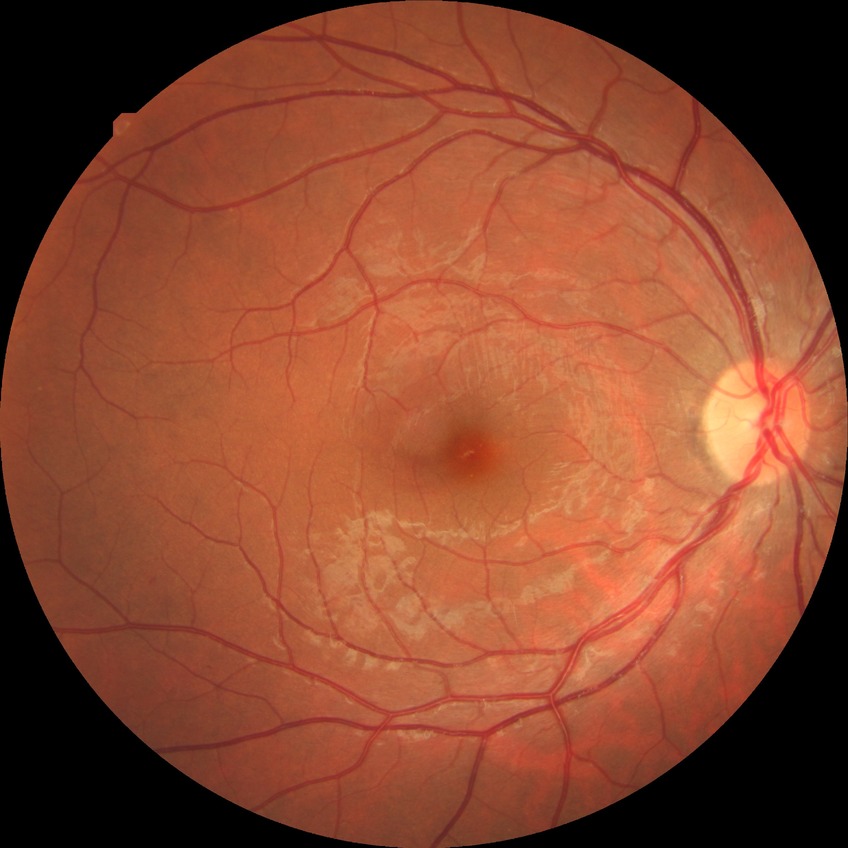

Diabetic retinopathy (DR) is no diabetic retinopathy (NDR).